2048x1536
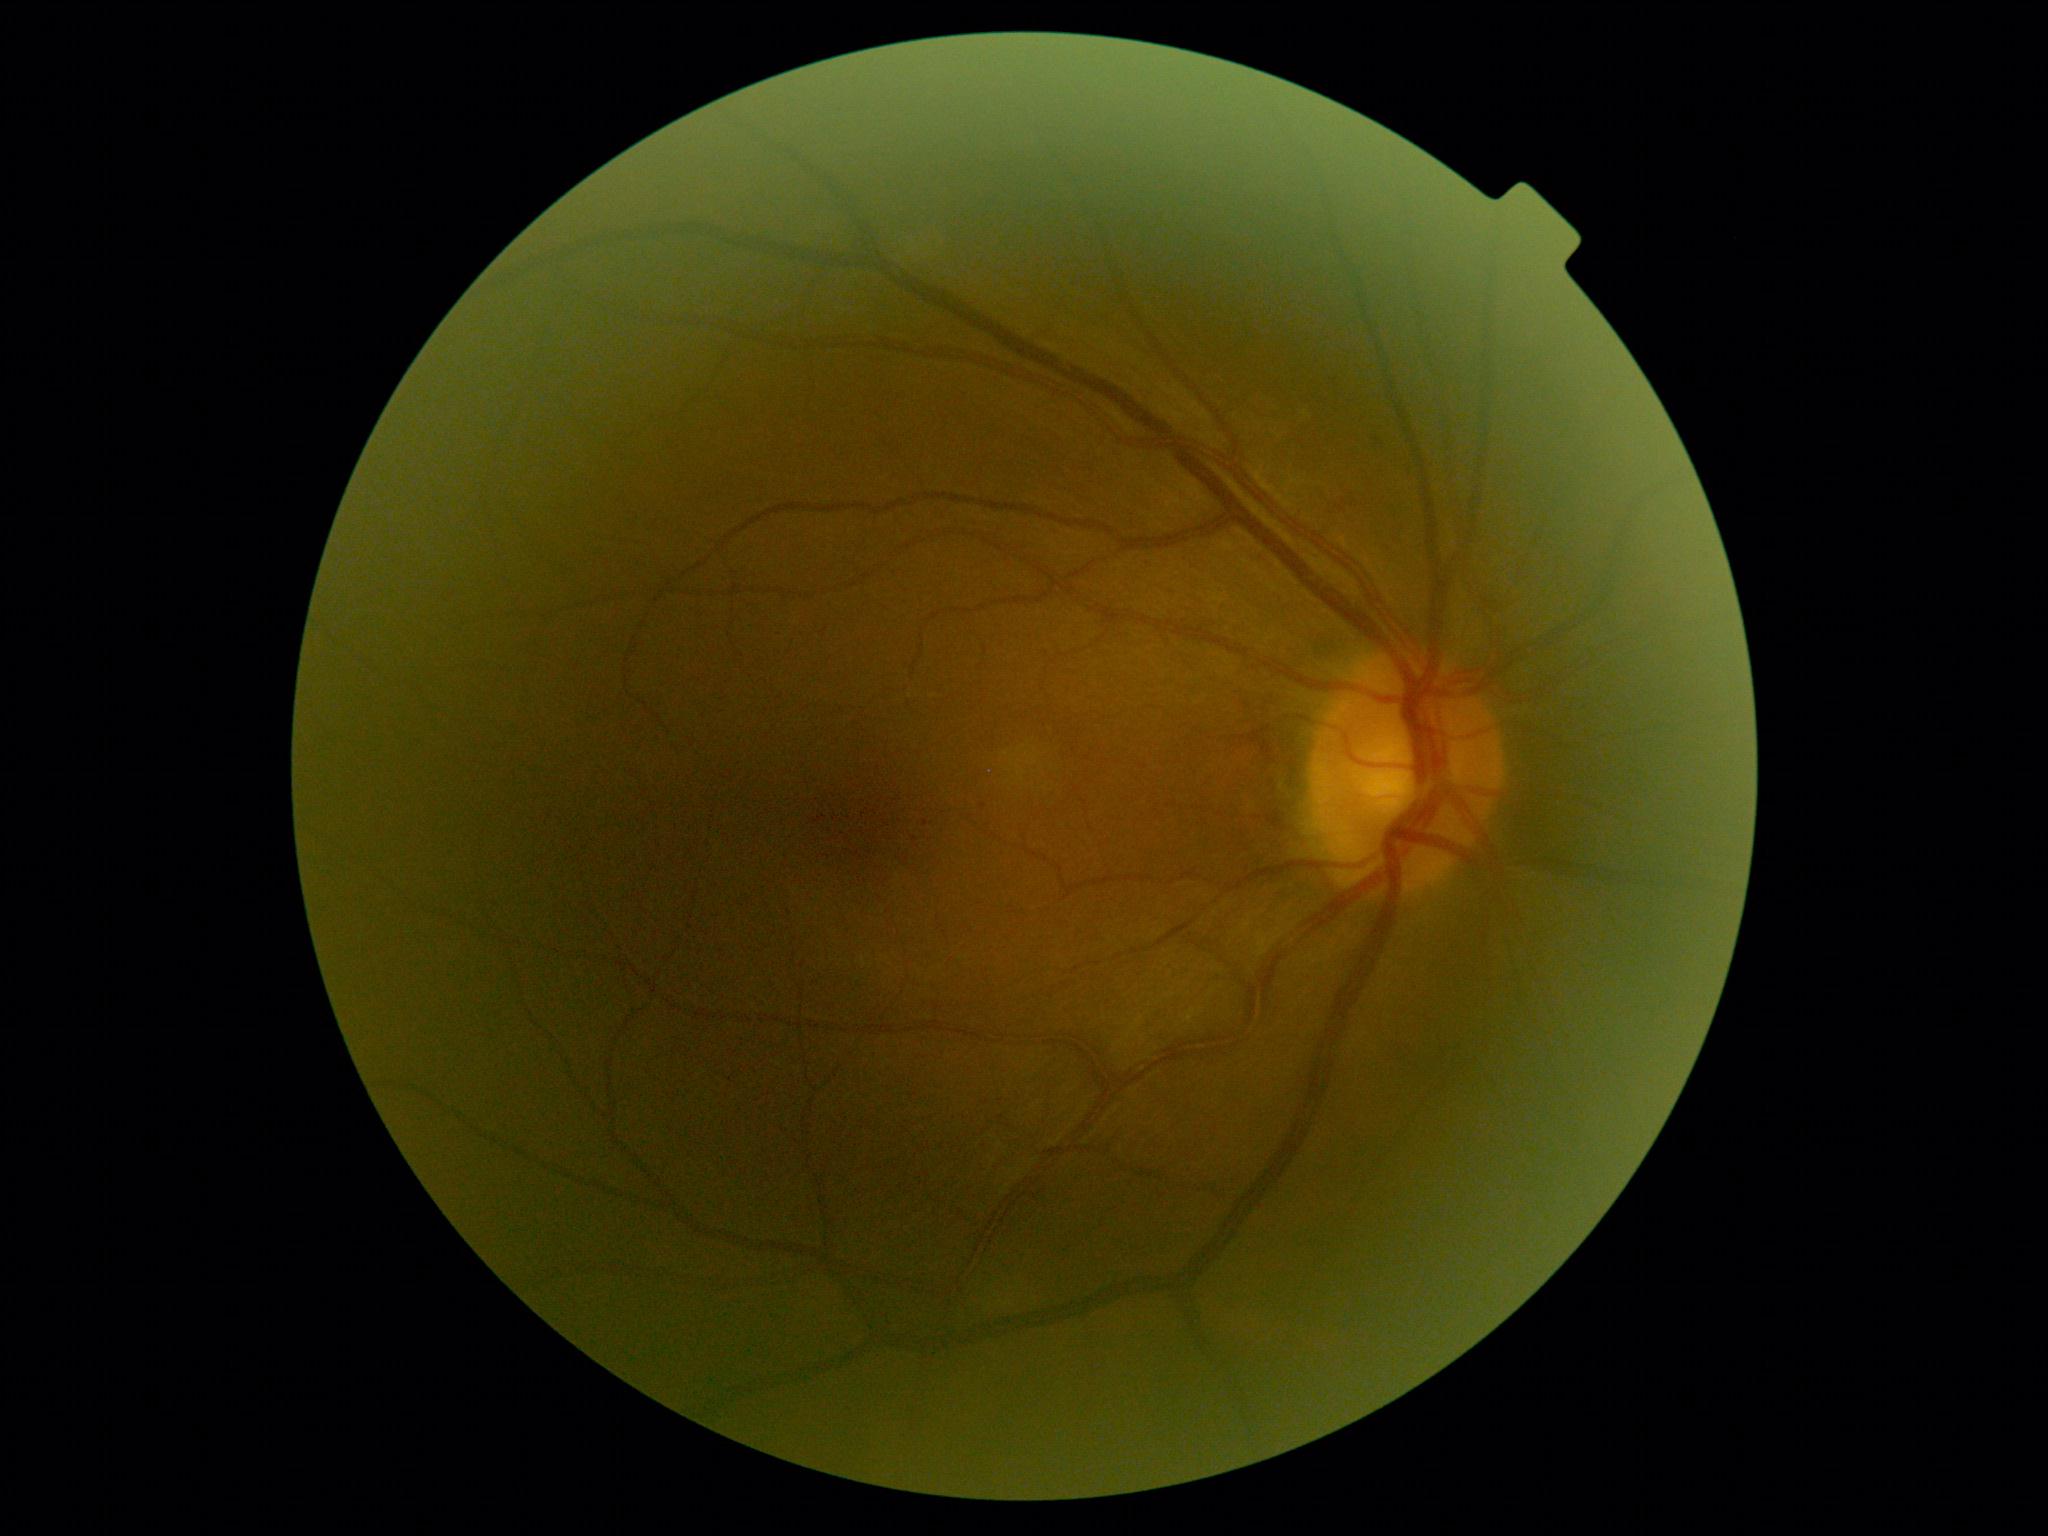
DR: 1/4.